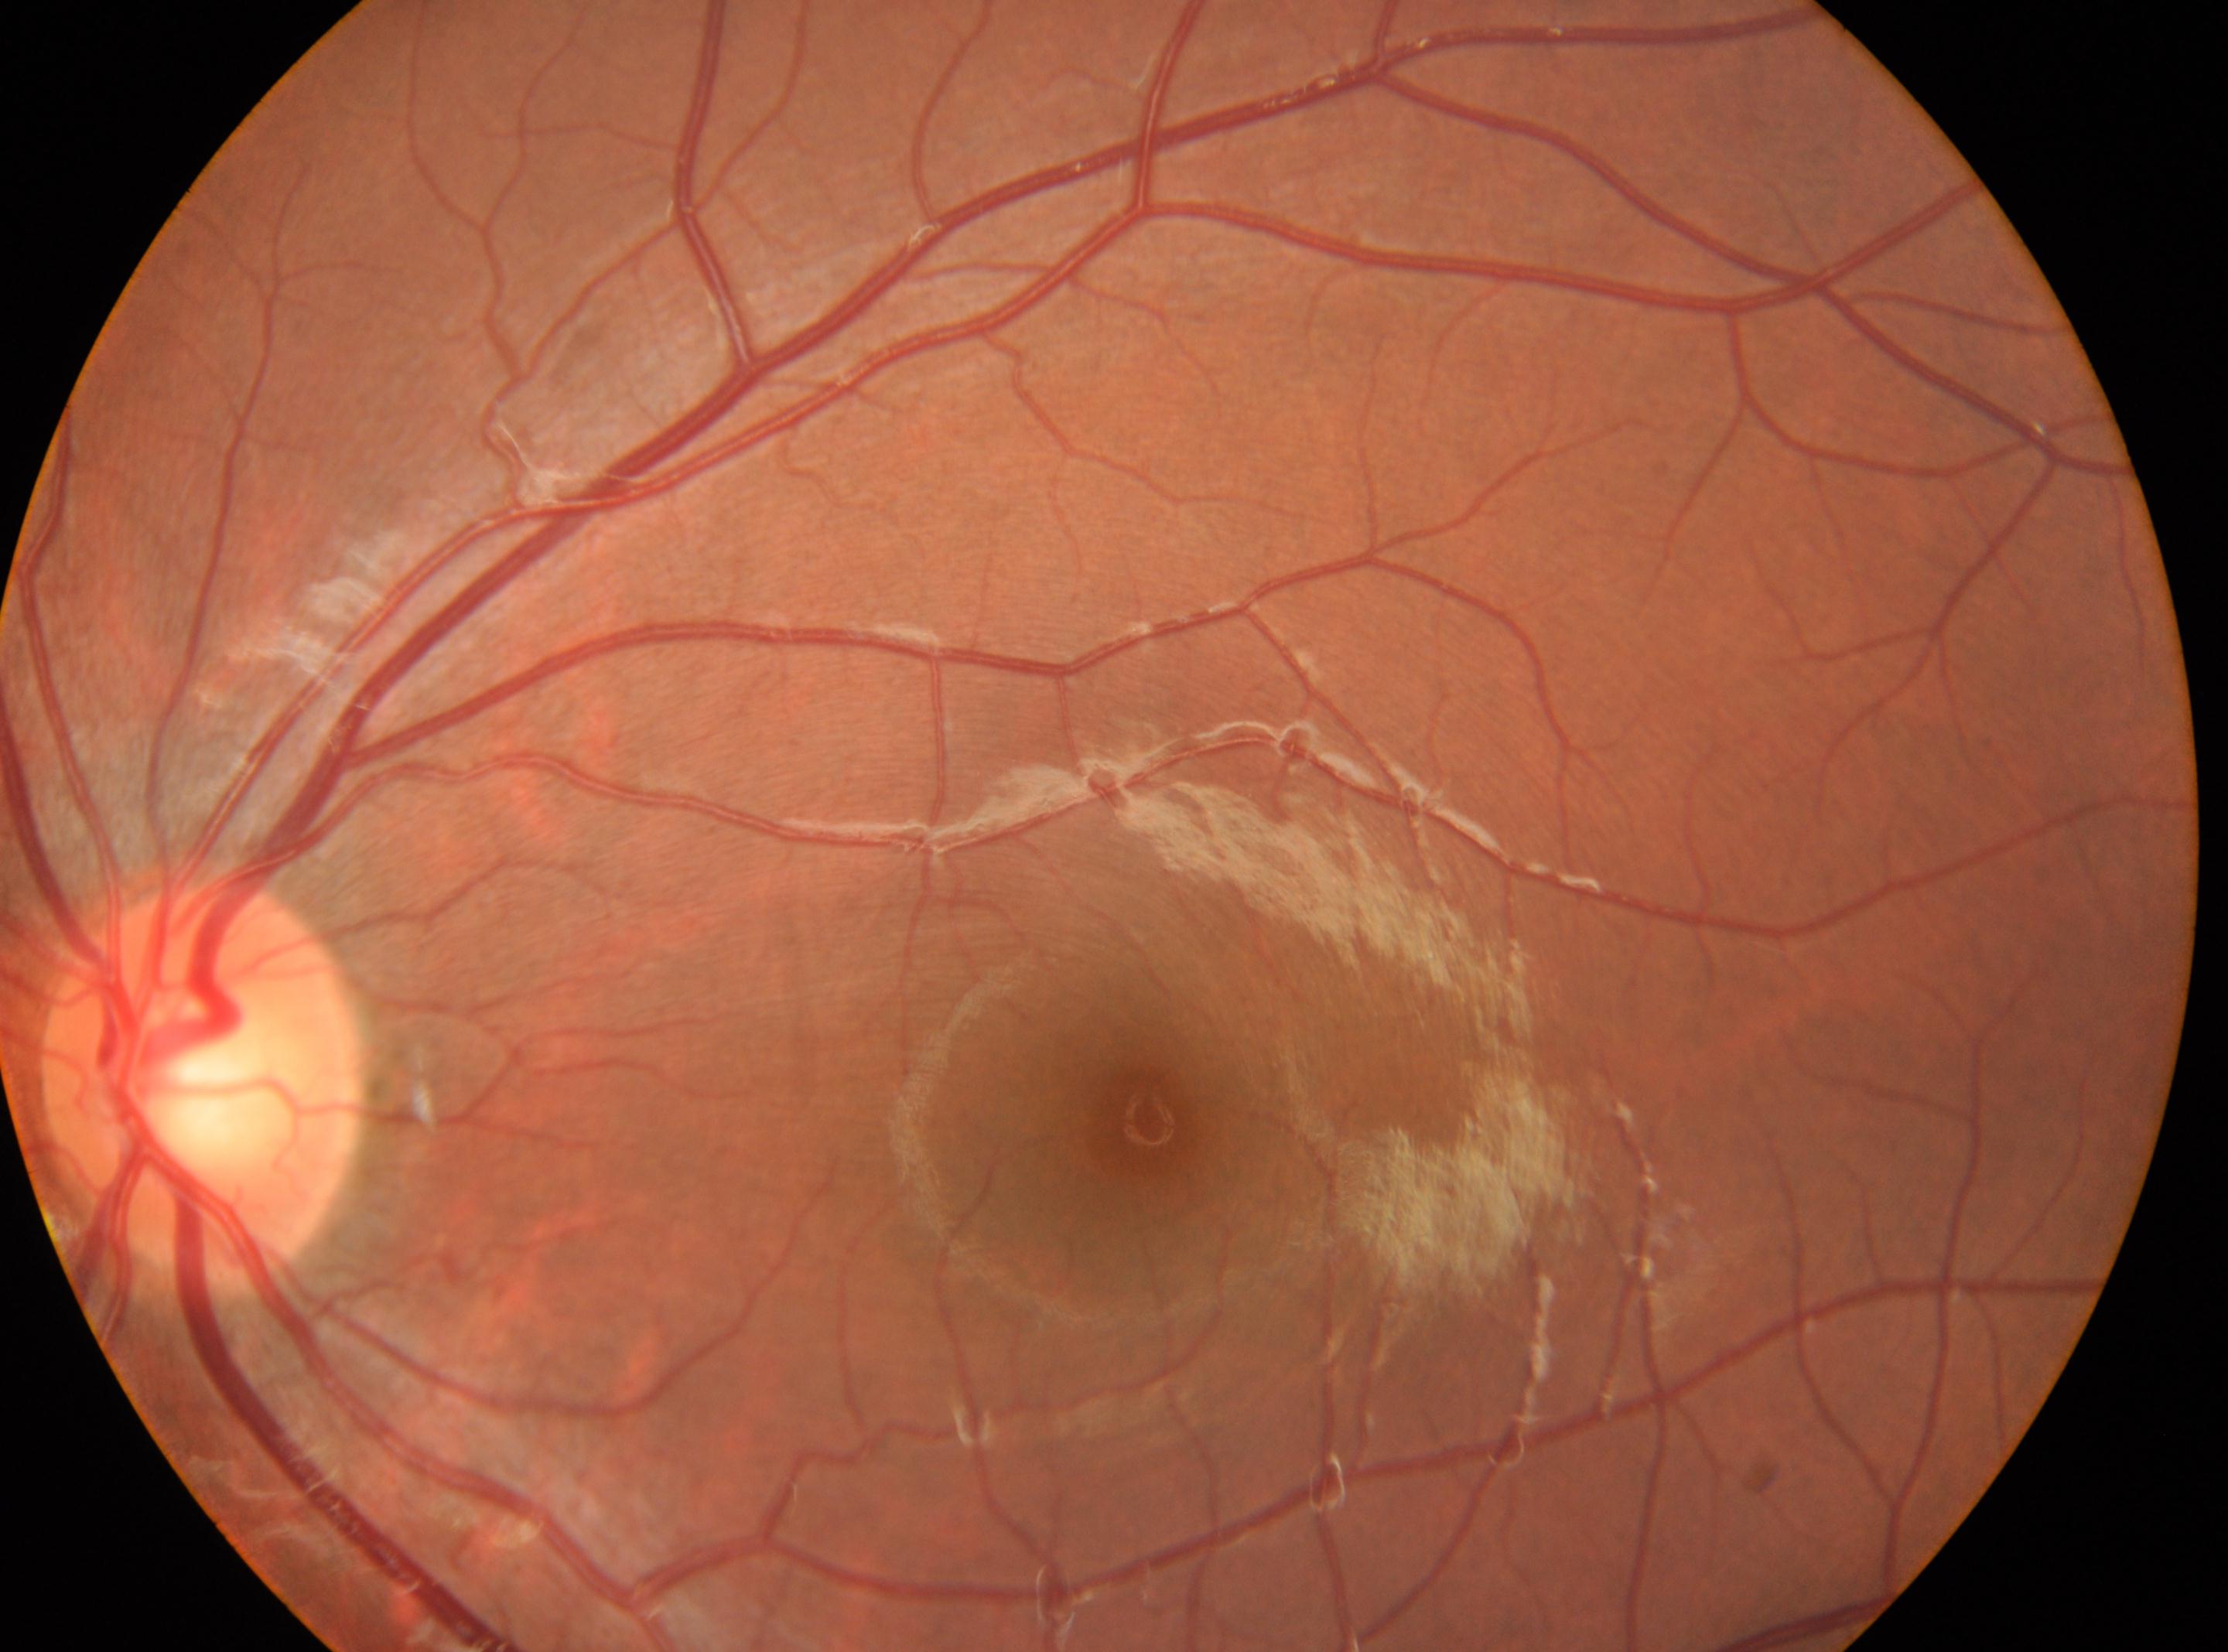
– laterality · left
– disc center · 204, 1081
– foveal center · 1148, 1120
– diabetic retinopathy severity · no apparent retinopathy (grade 0)